848x848; modified Davis classification.
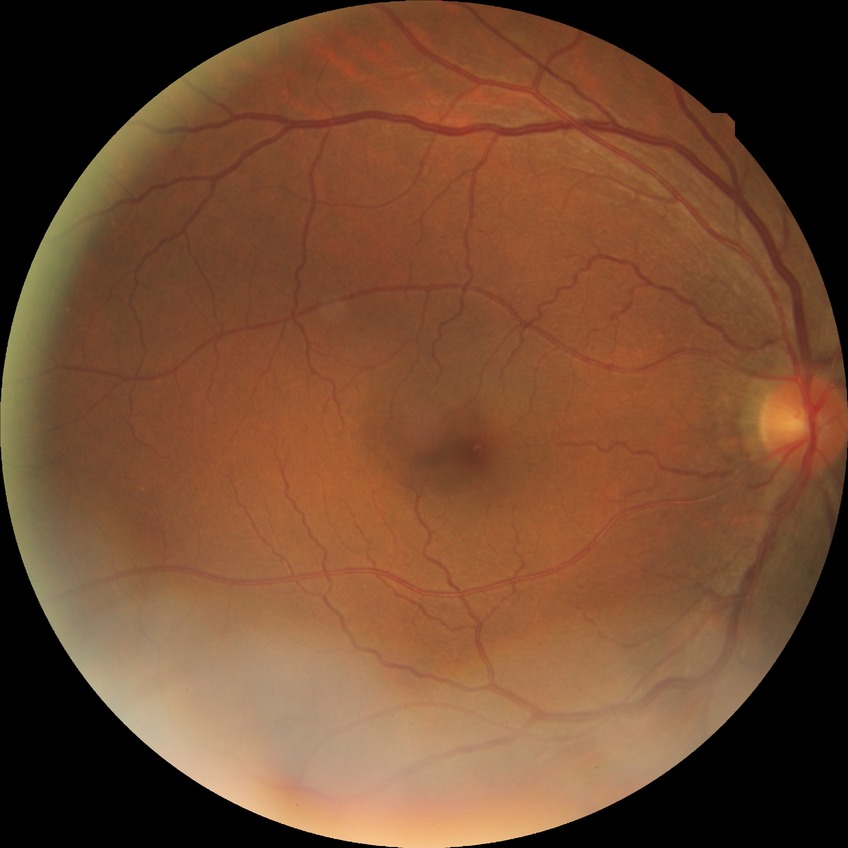 Modified Davis classification is no diabetic retinopathy.